Davis DR grading; nonmydriatic fundus photograph; NIDEK AFC-230 fundus camera; 45-degree field of view: 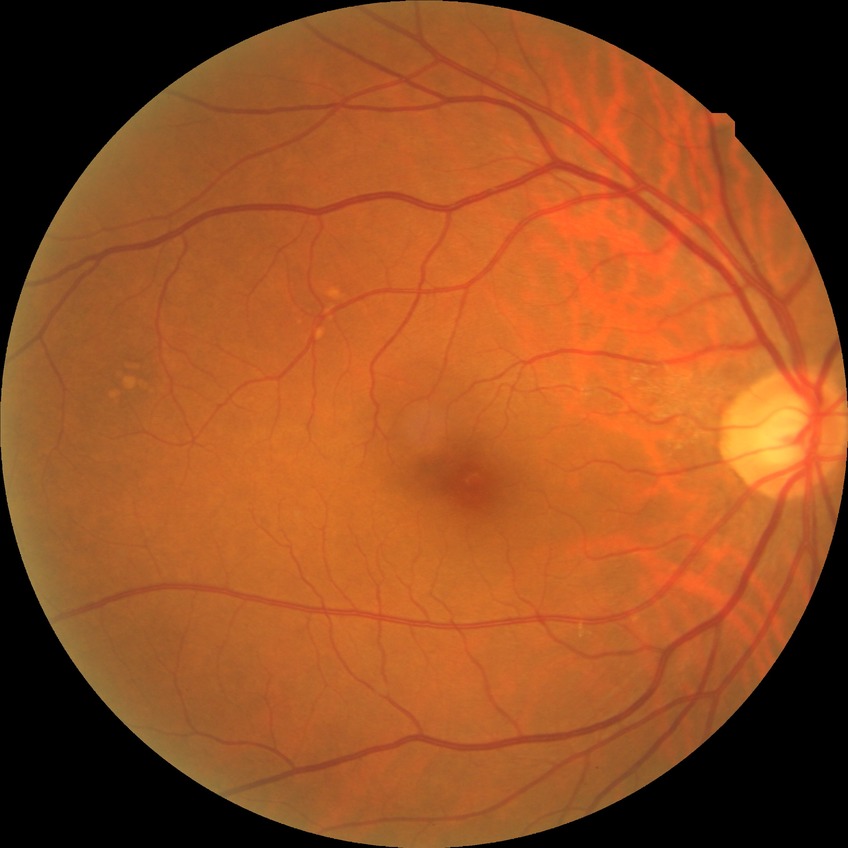

Assessment:
– diabetic retinopathy severity: no diabetic retinopathy